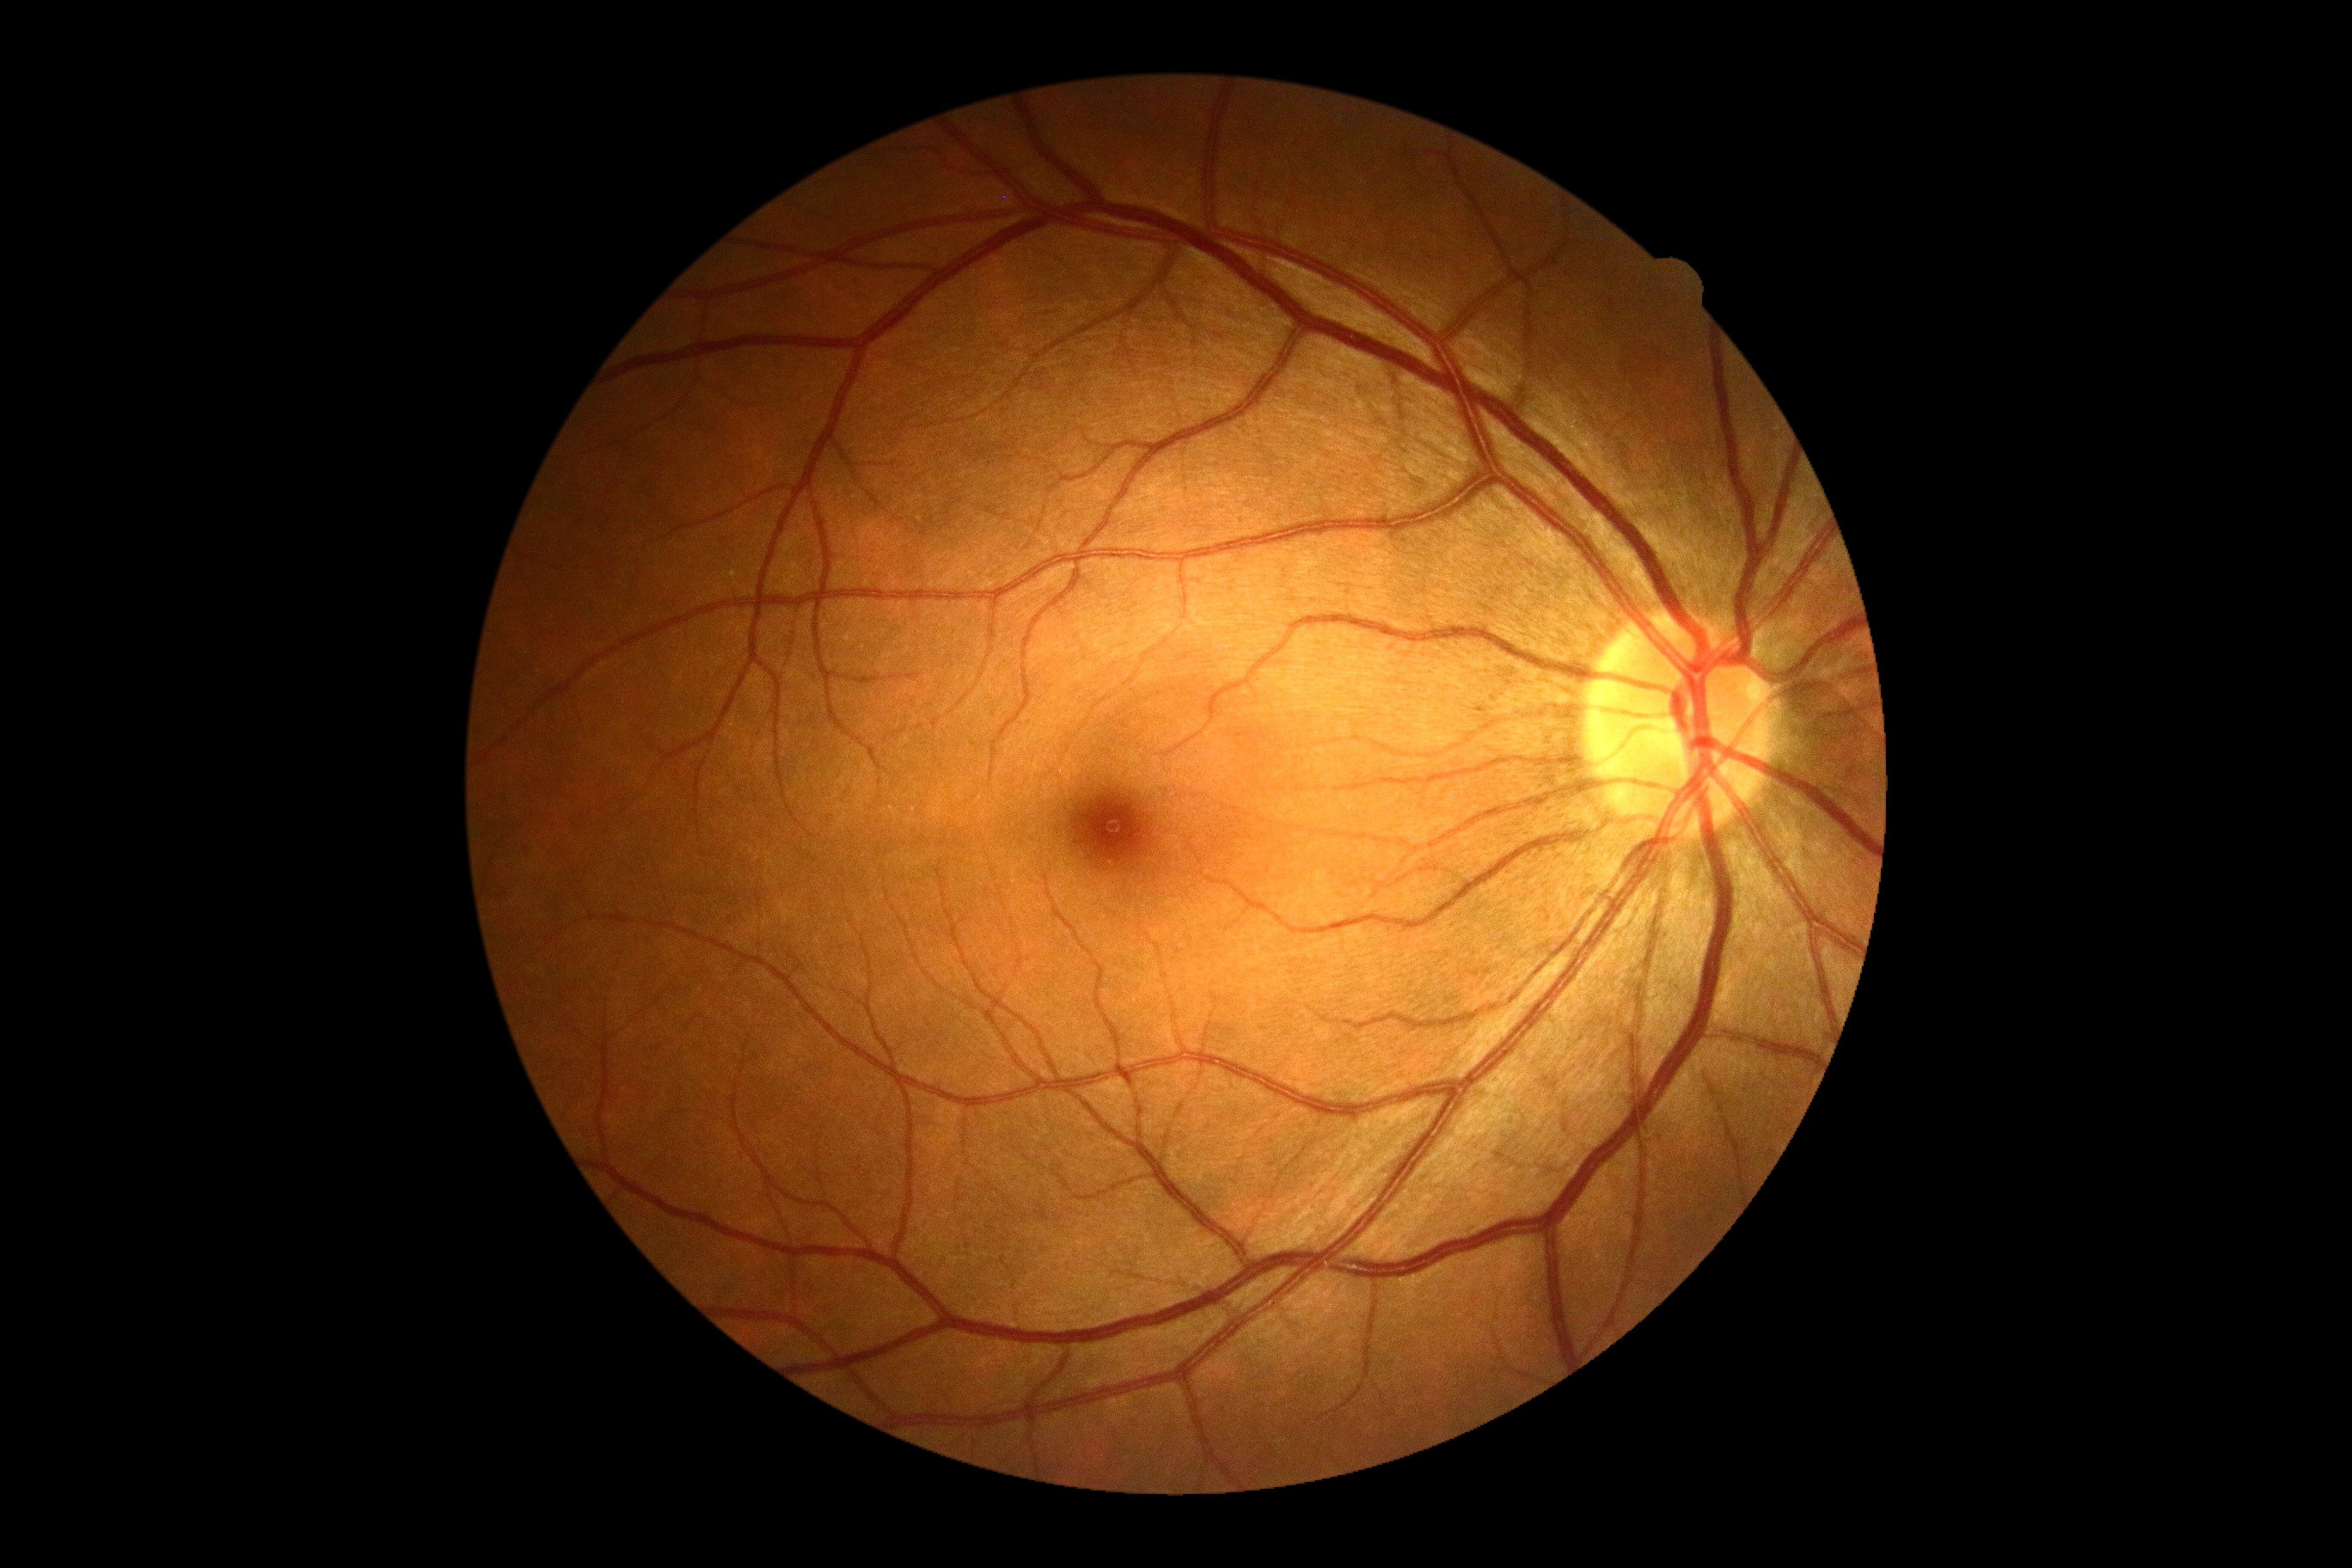

DR severity: no apparent diabetic retinopathy (grade 0).